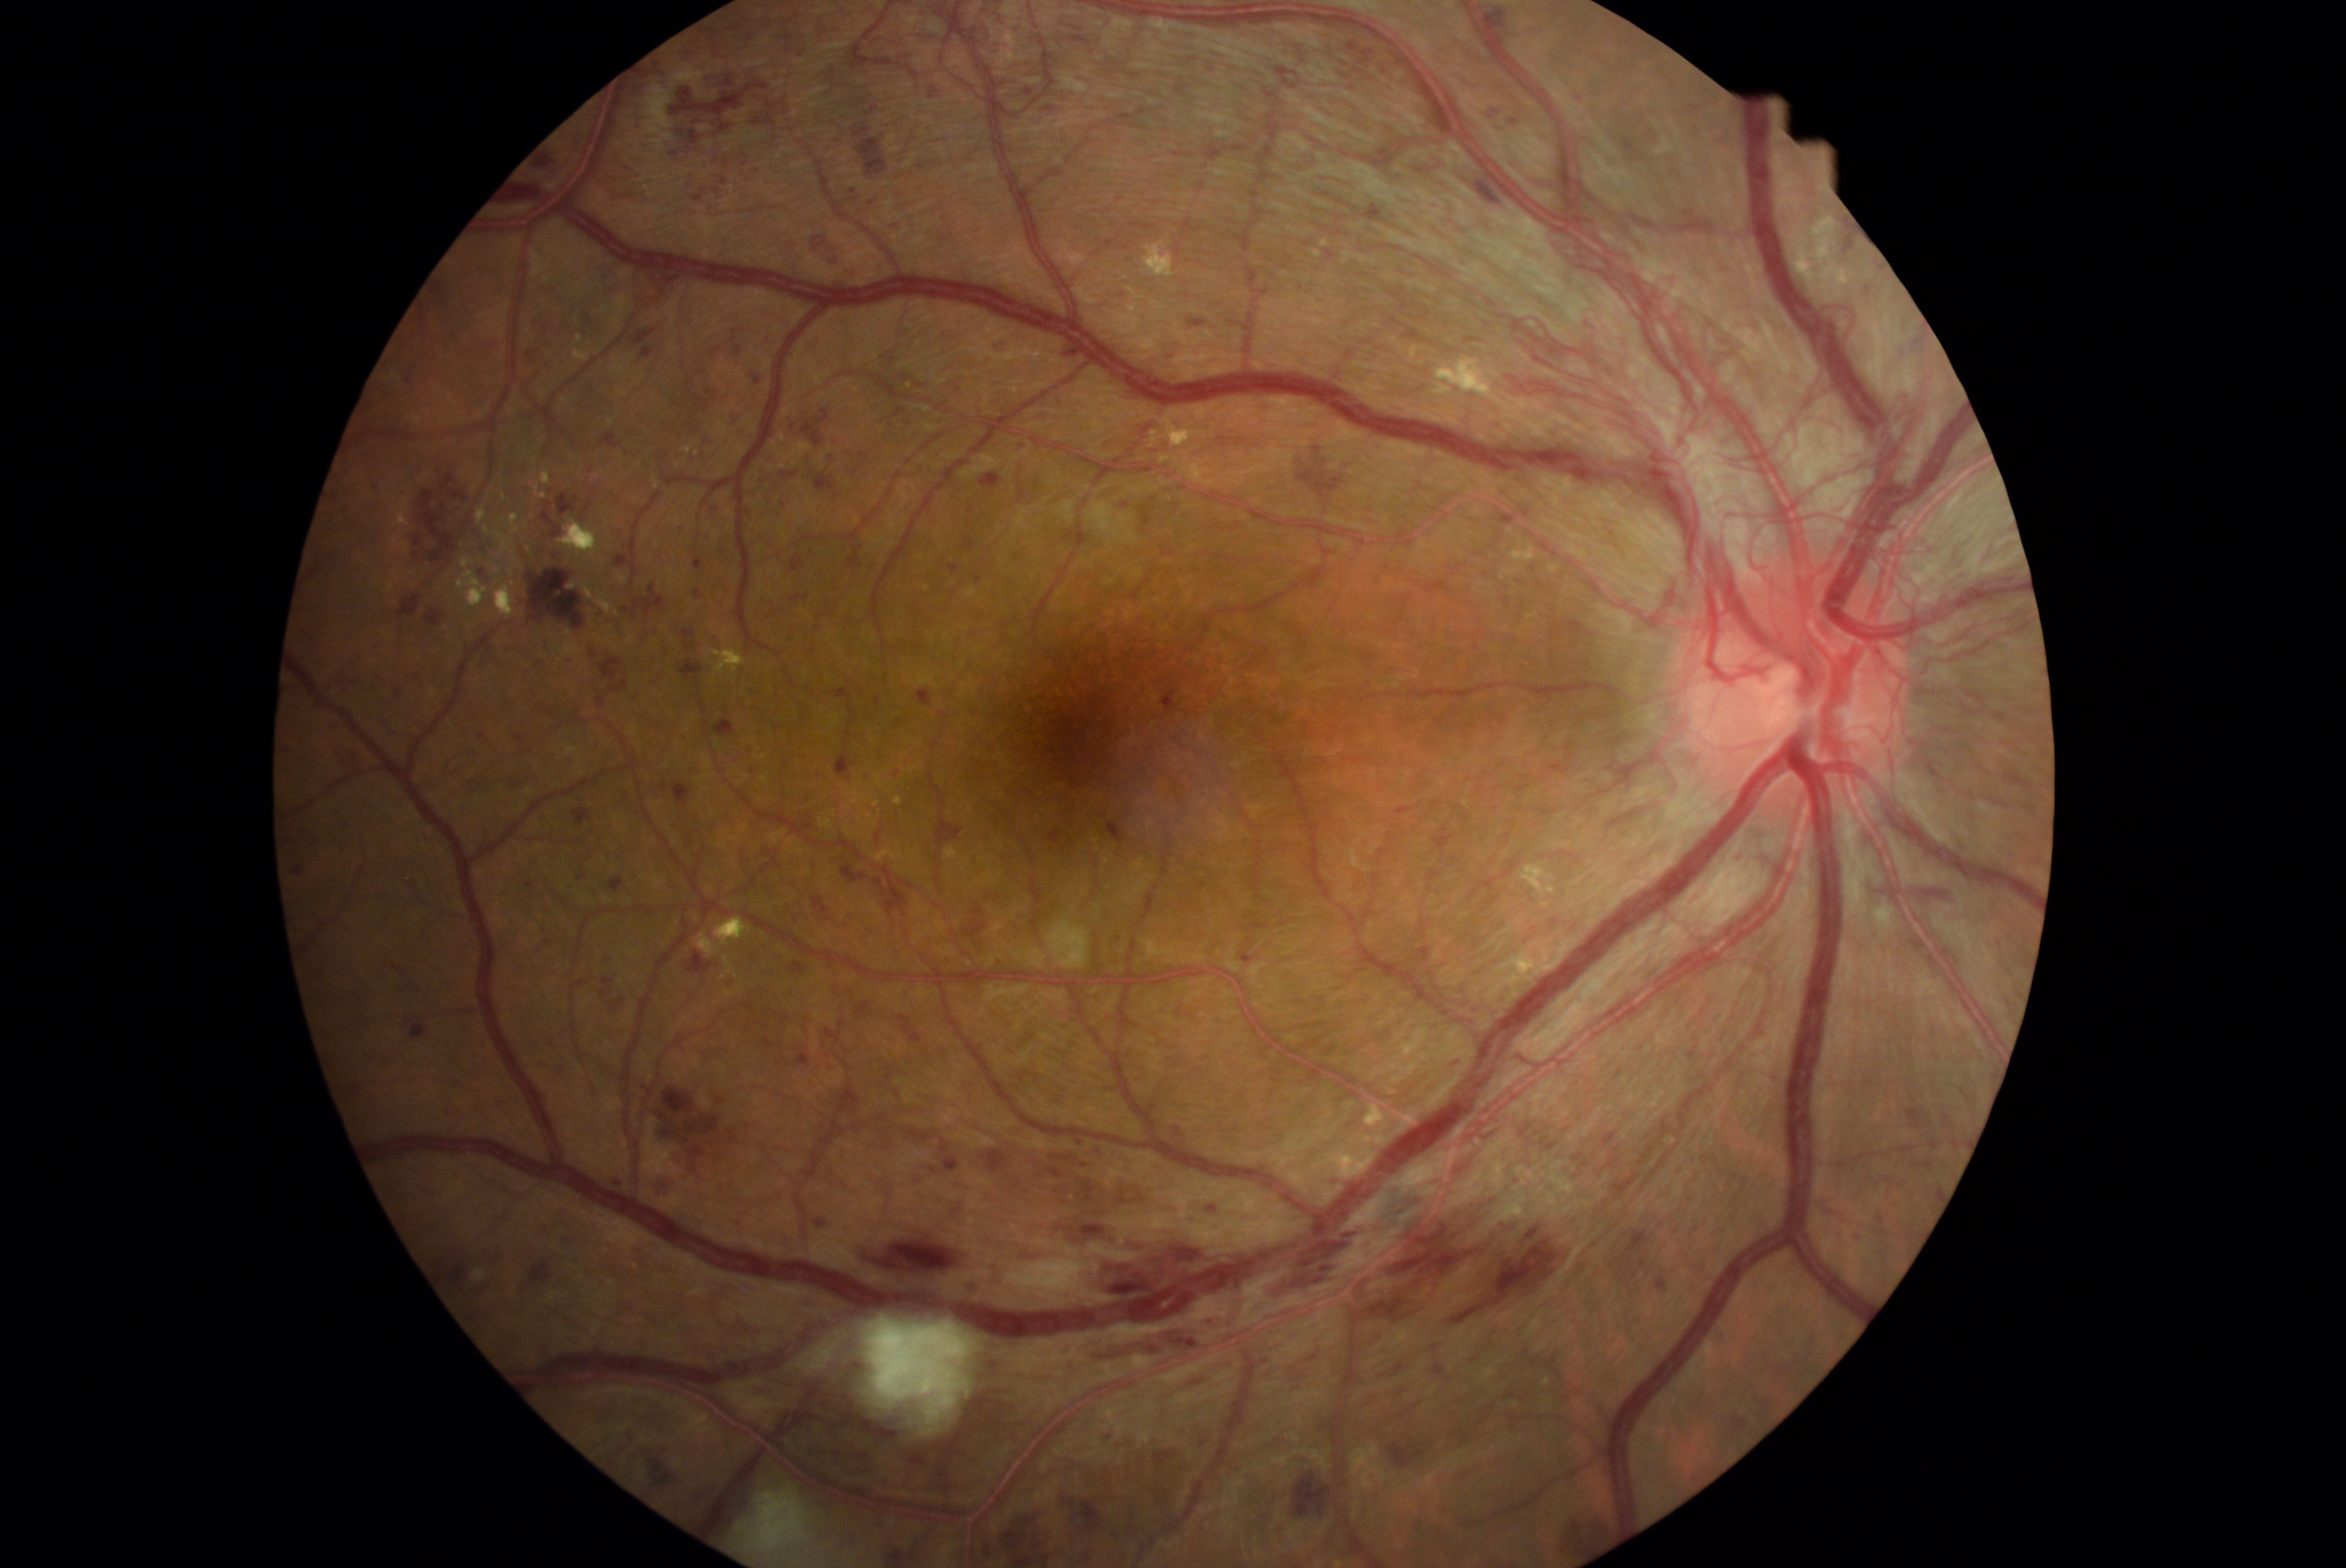 {"partial":true,"dr_grade":4,"dr_grade_name":"PDR","lesions":{"he":[[1464,169,1505,208],[703,438,714,446],[603,978,614,987],[1287,1456,1335,1520],[895,156,943,178],[1020,1075,1026,1083],[711,633,722,653],[695,194,703,201],[860,772,874,782],[398,593,423,620],[531,1340,553,1363],[639,1083,761,1185],[982,471,1003,492],[476,564,493,584],[562,655,575,667],[857,1001,871,1020],[887,217,904,234],[391,684,404,700]],"he_small_approx":[[924,1049],[702,373]]}}